1932 by 1916 pixels, FOV: 45 degrees, fundus photo.
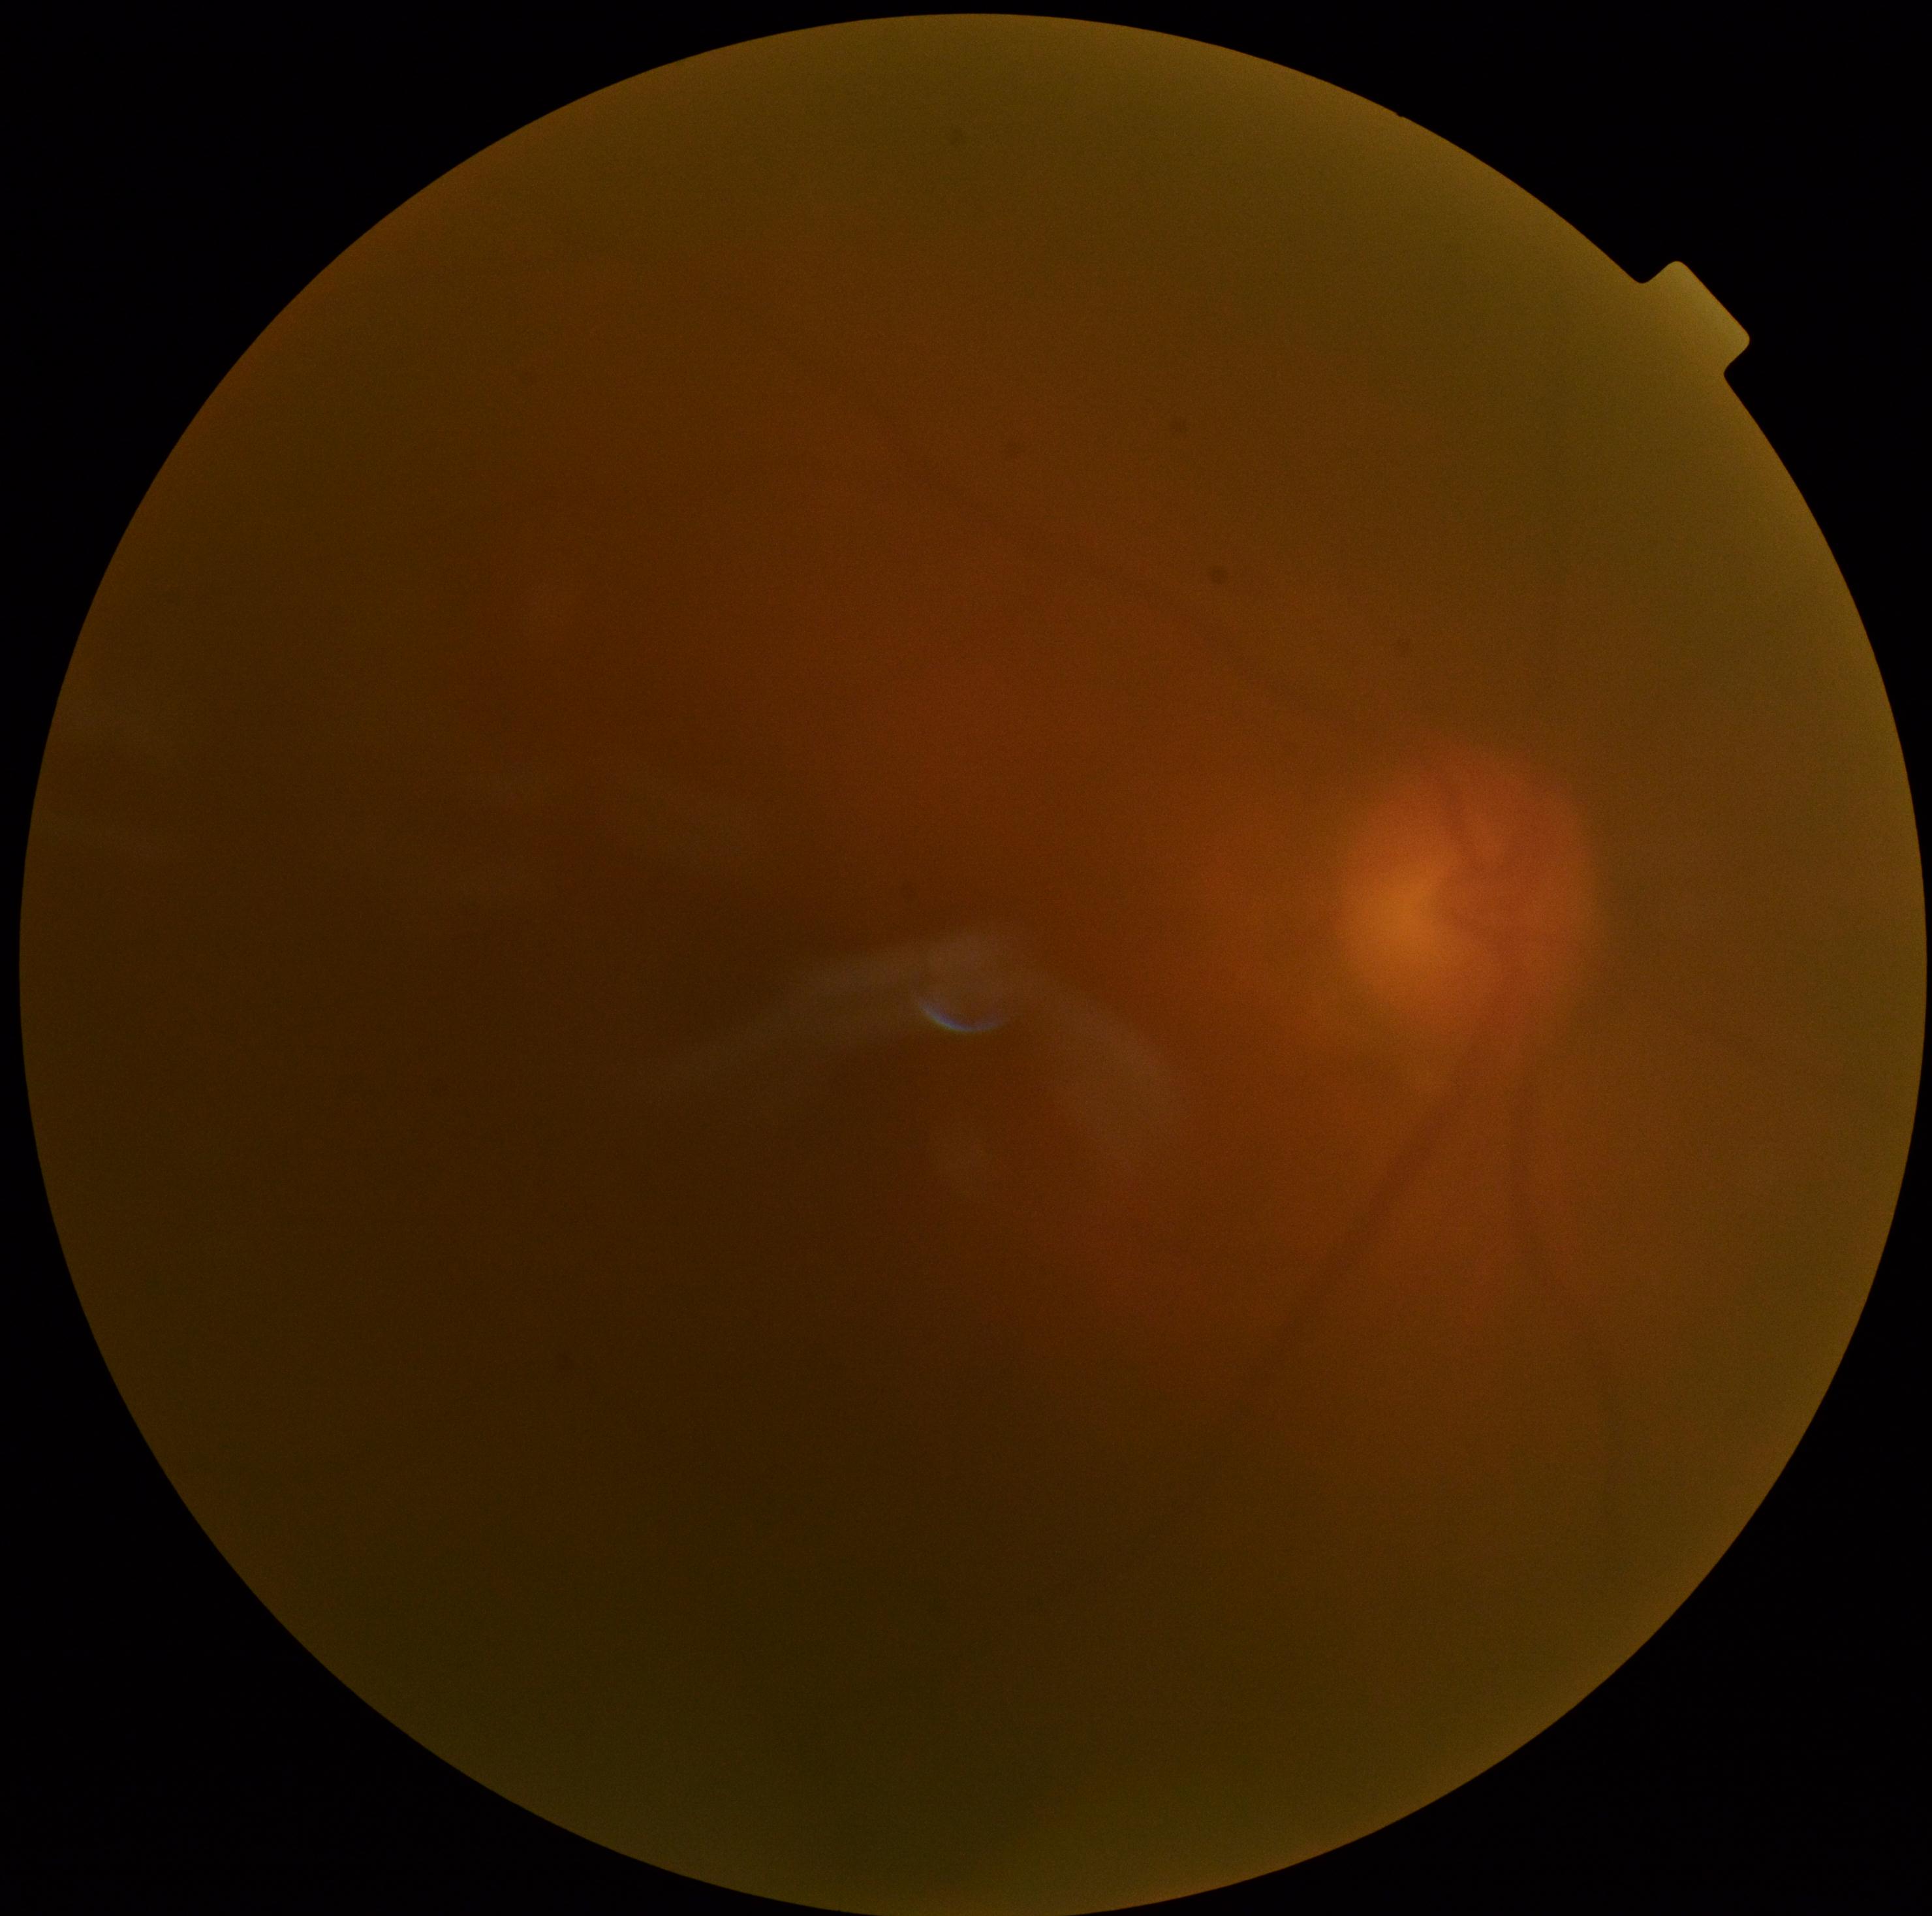
DR: ungradable due to poor image quality.
Quality too poor to assess for DR.